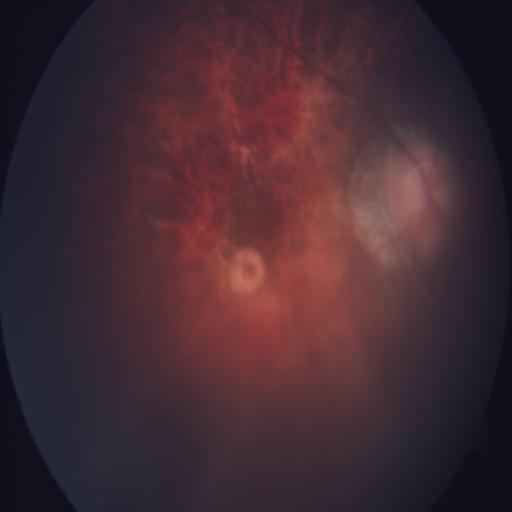 Abnormalities: myopia.